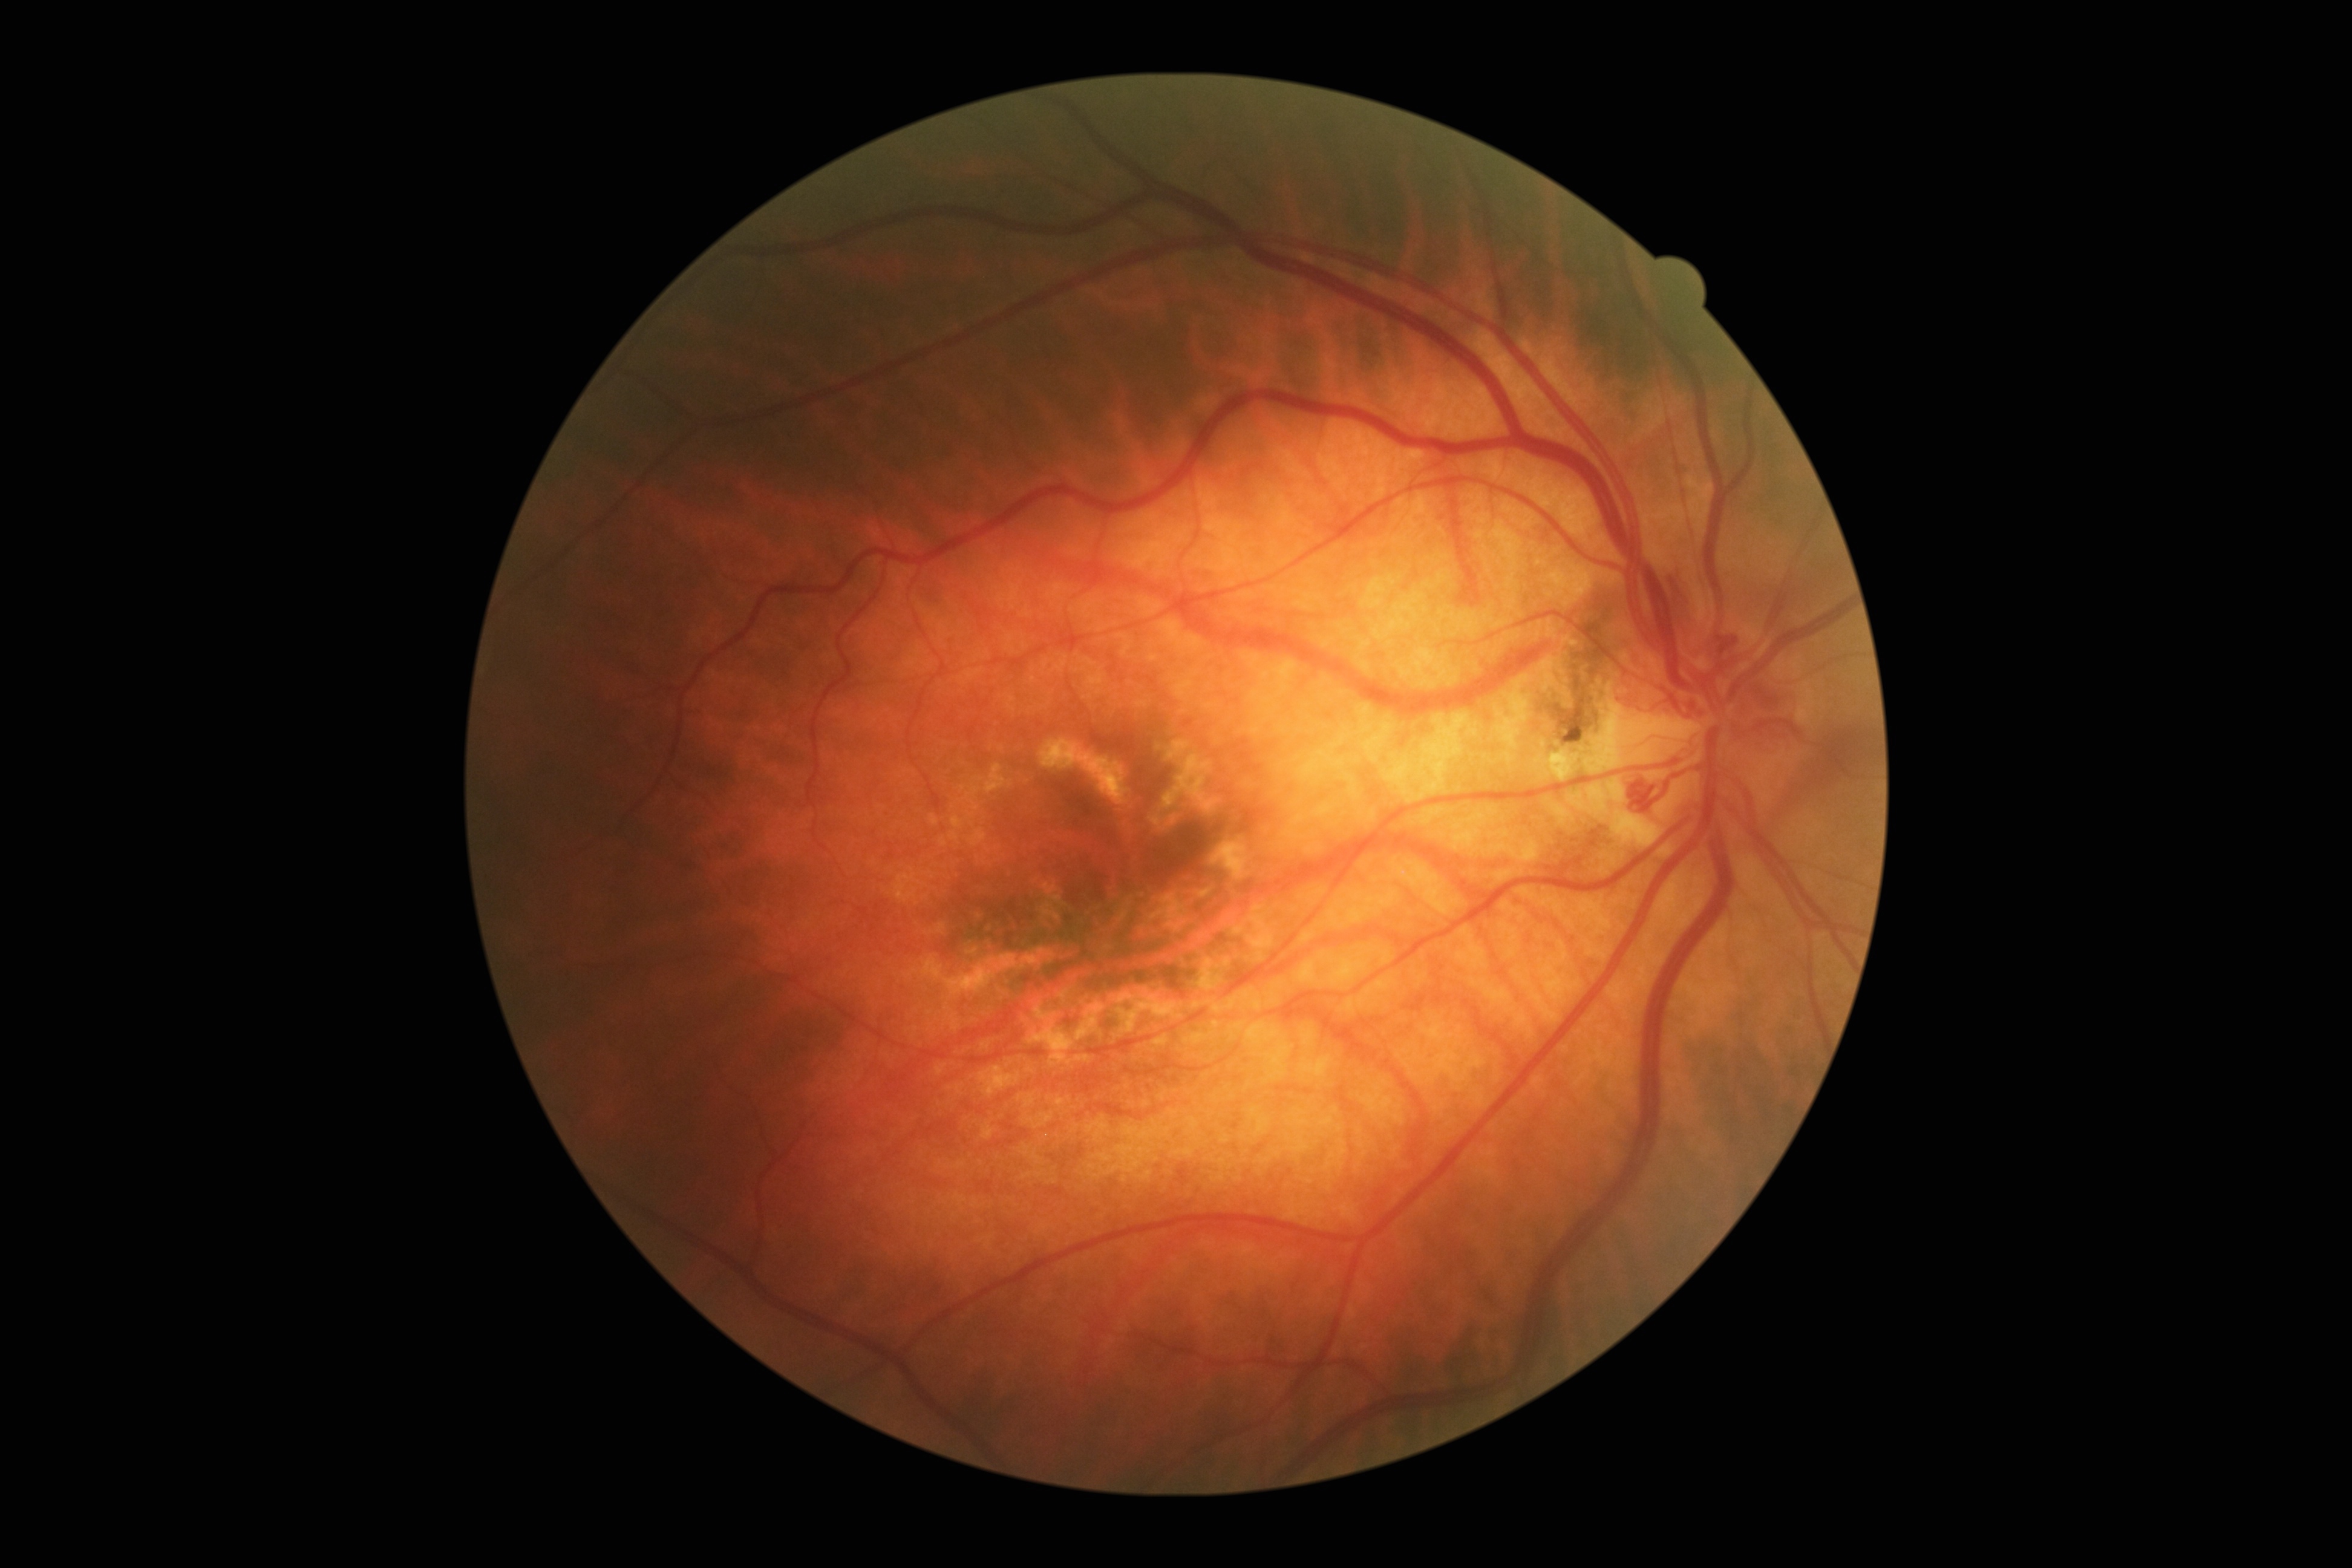 DR grade: 4 (PDR).
The retinopathy is classified as proliferative diabetic retinopathy.